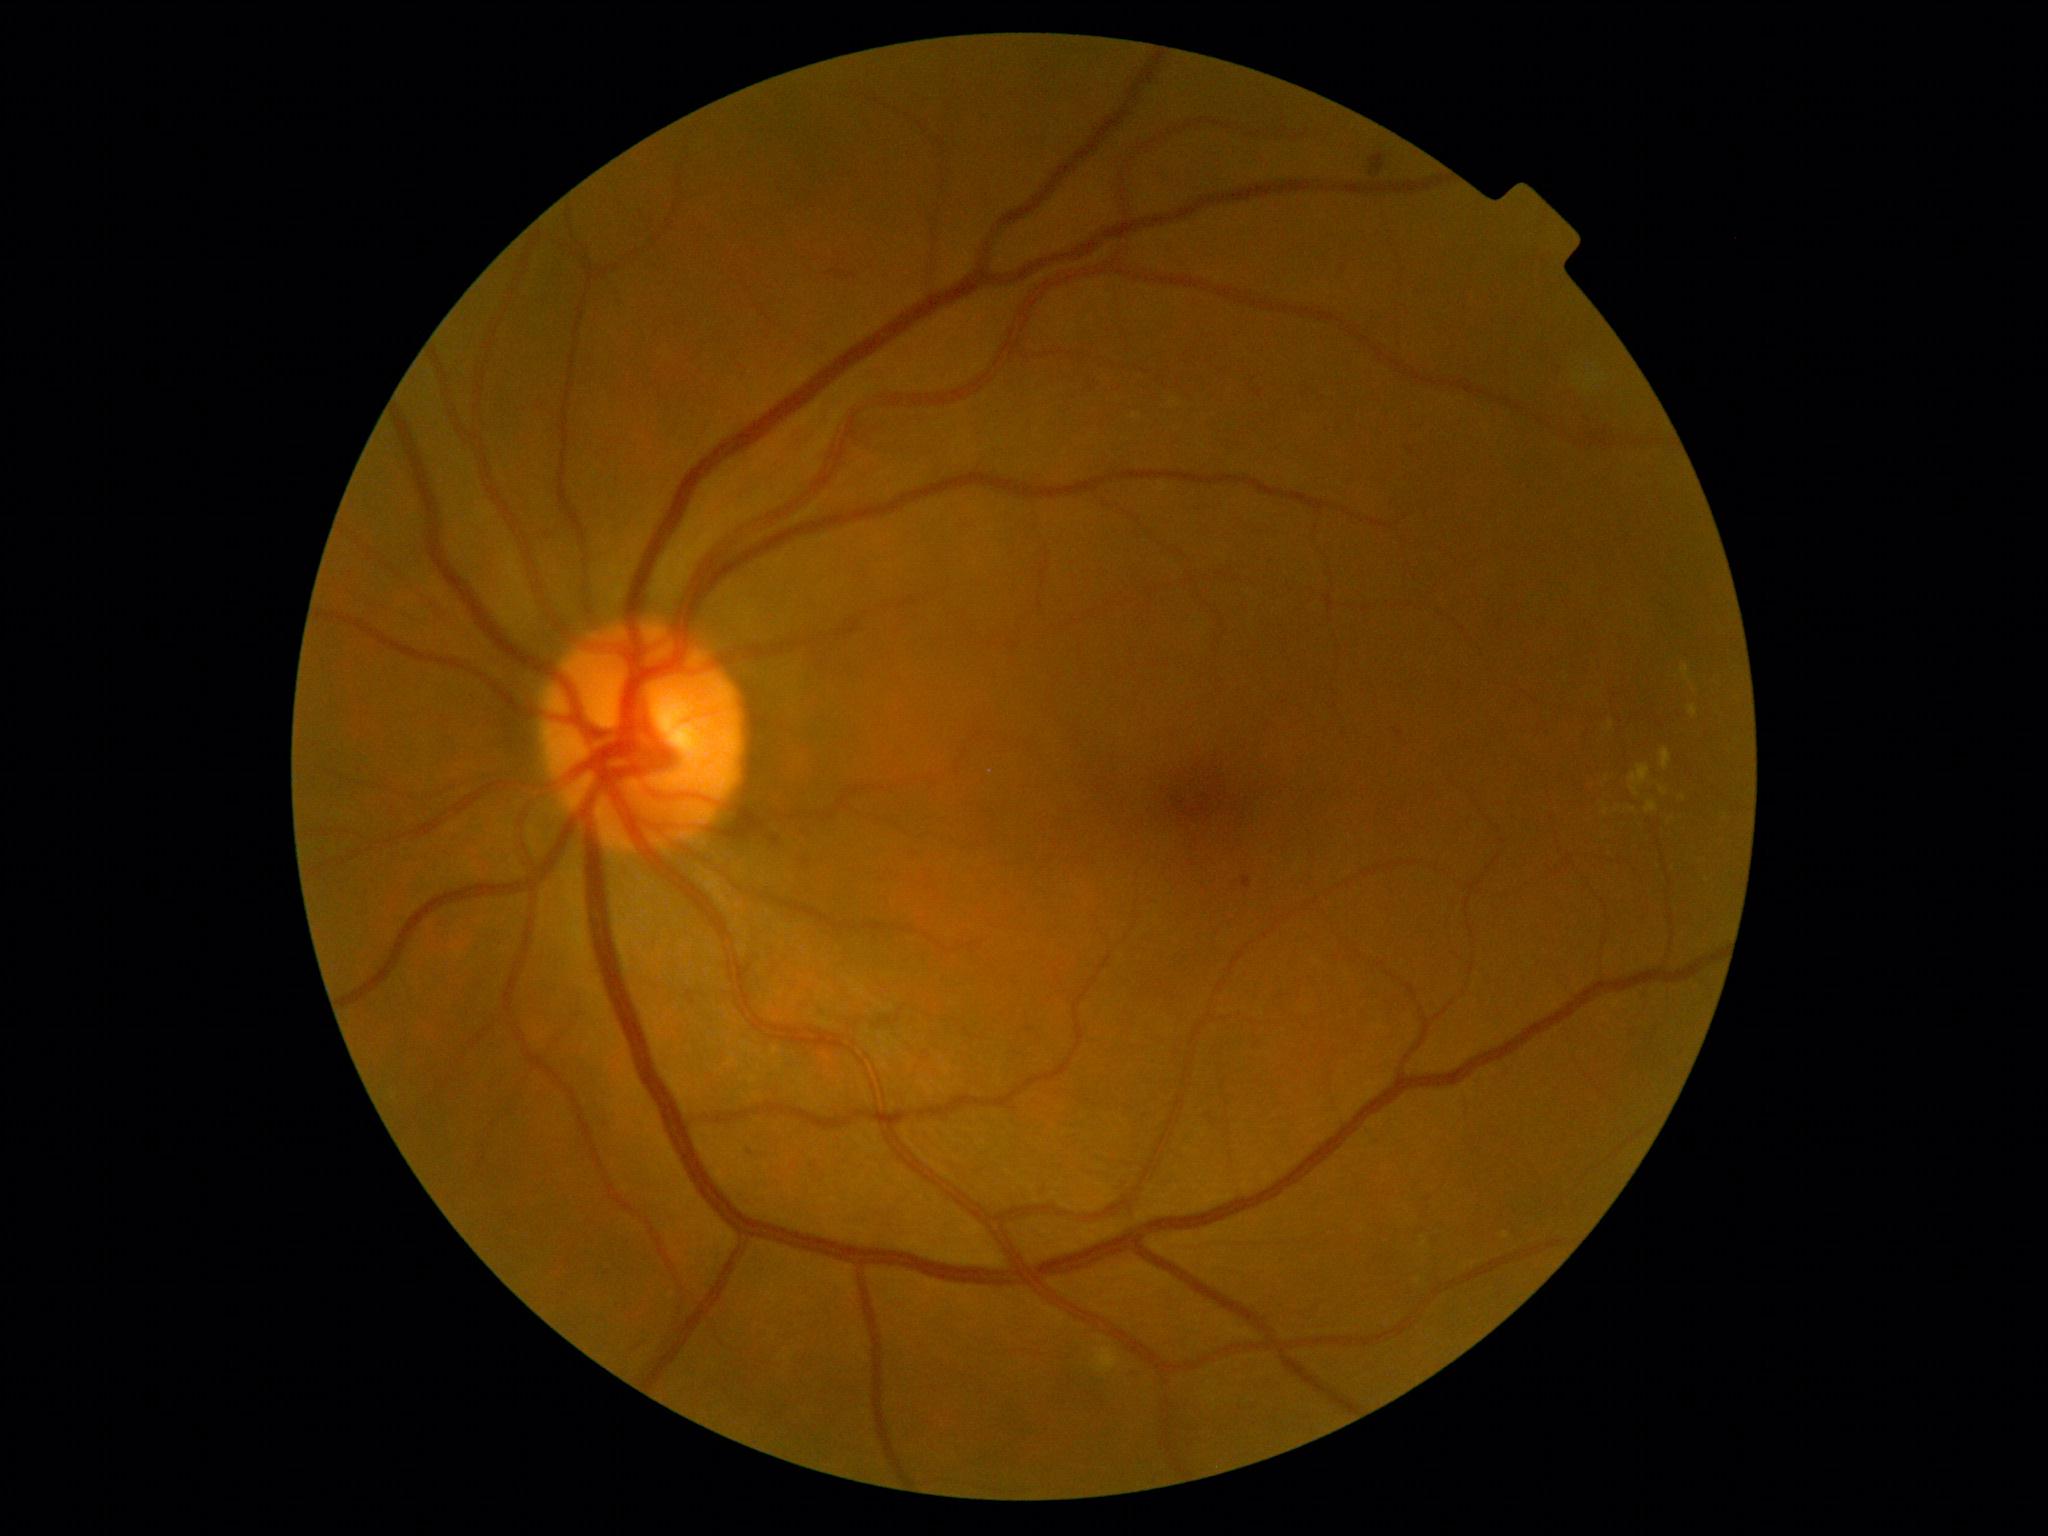
diabetic retinopathy (DR): grade 2 — more than just microaneurysms but less than severe NPDR, DR class: non-proliferative diabetic retinopathy.